FOV: 200 degrees; ultra-widefield fundus photograph; 1924 by 1556 pixels:
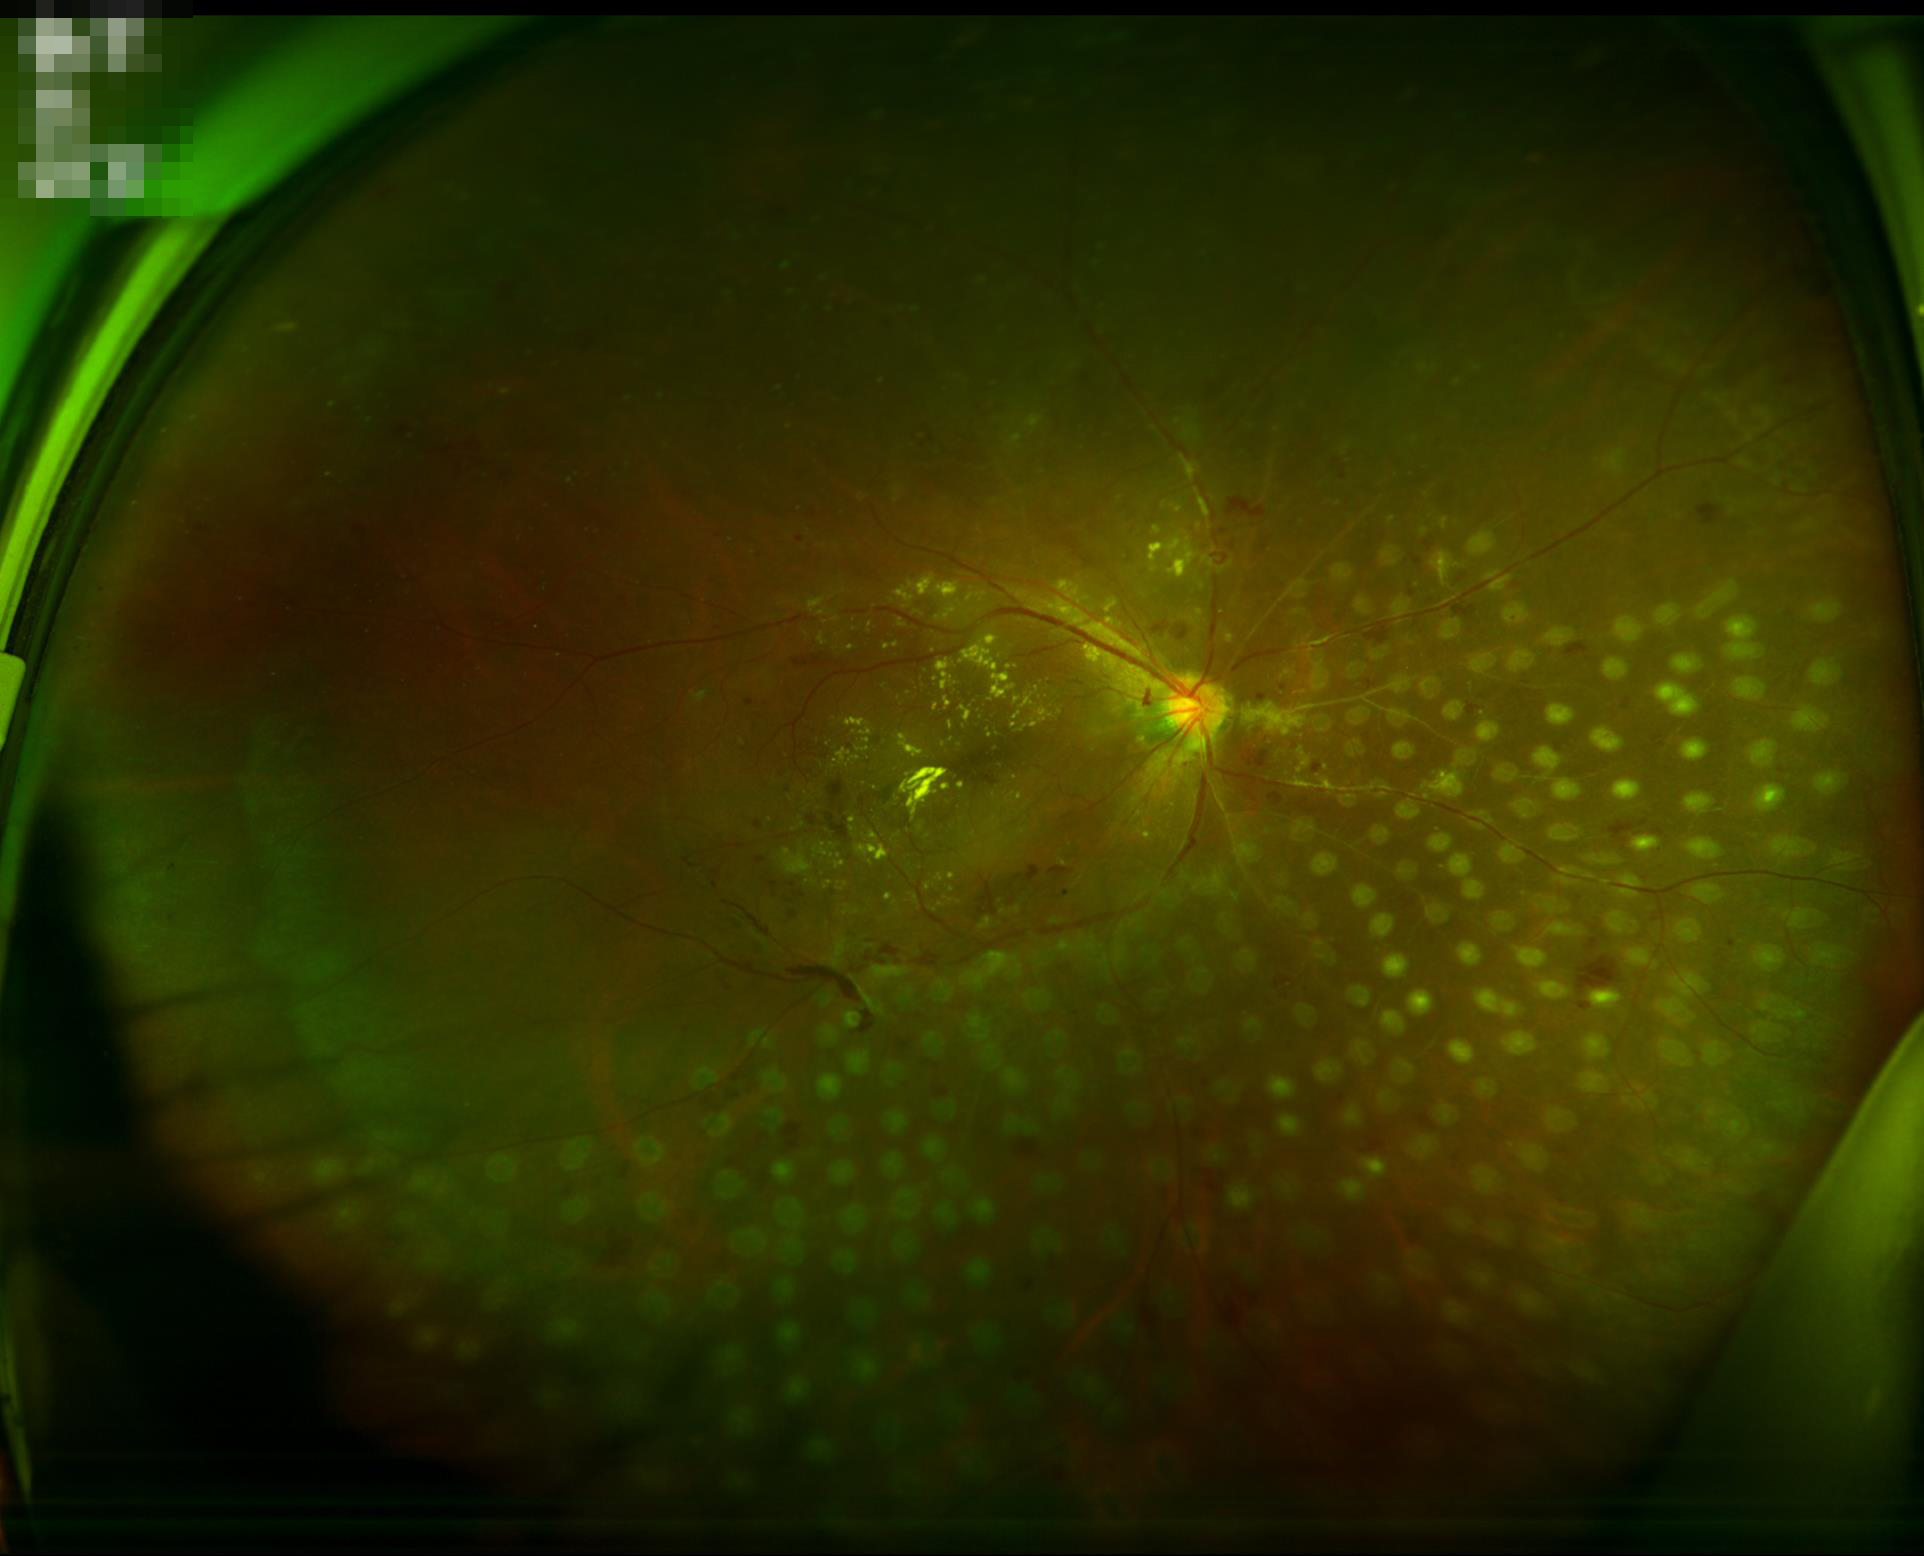
Noticeable blur in the optic disc, vessels, or background. Contrast is good. Image quality is inadequate for diagnostic use.